45° field of view.
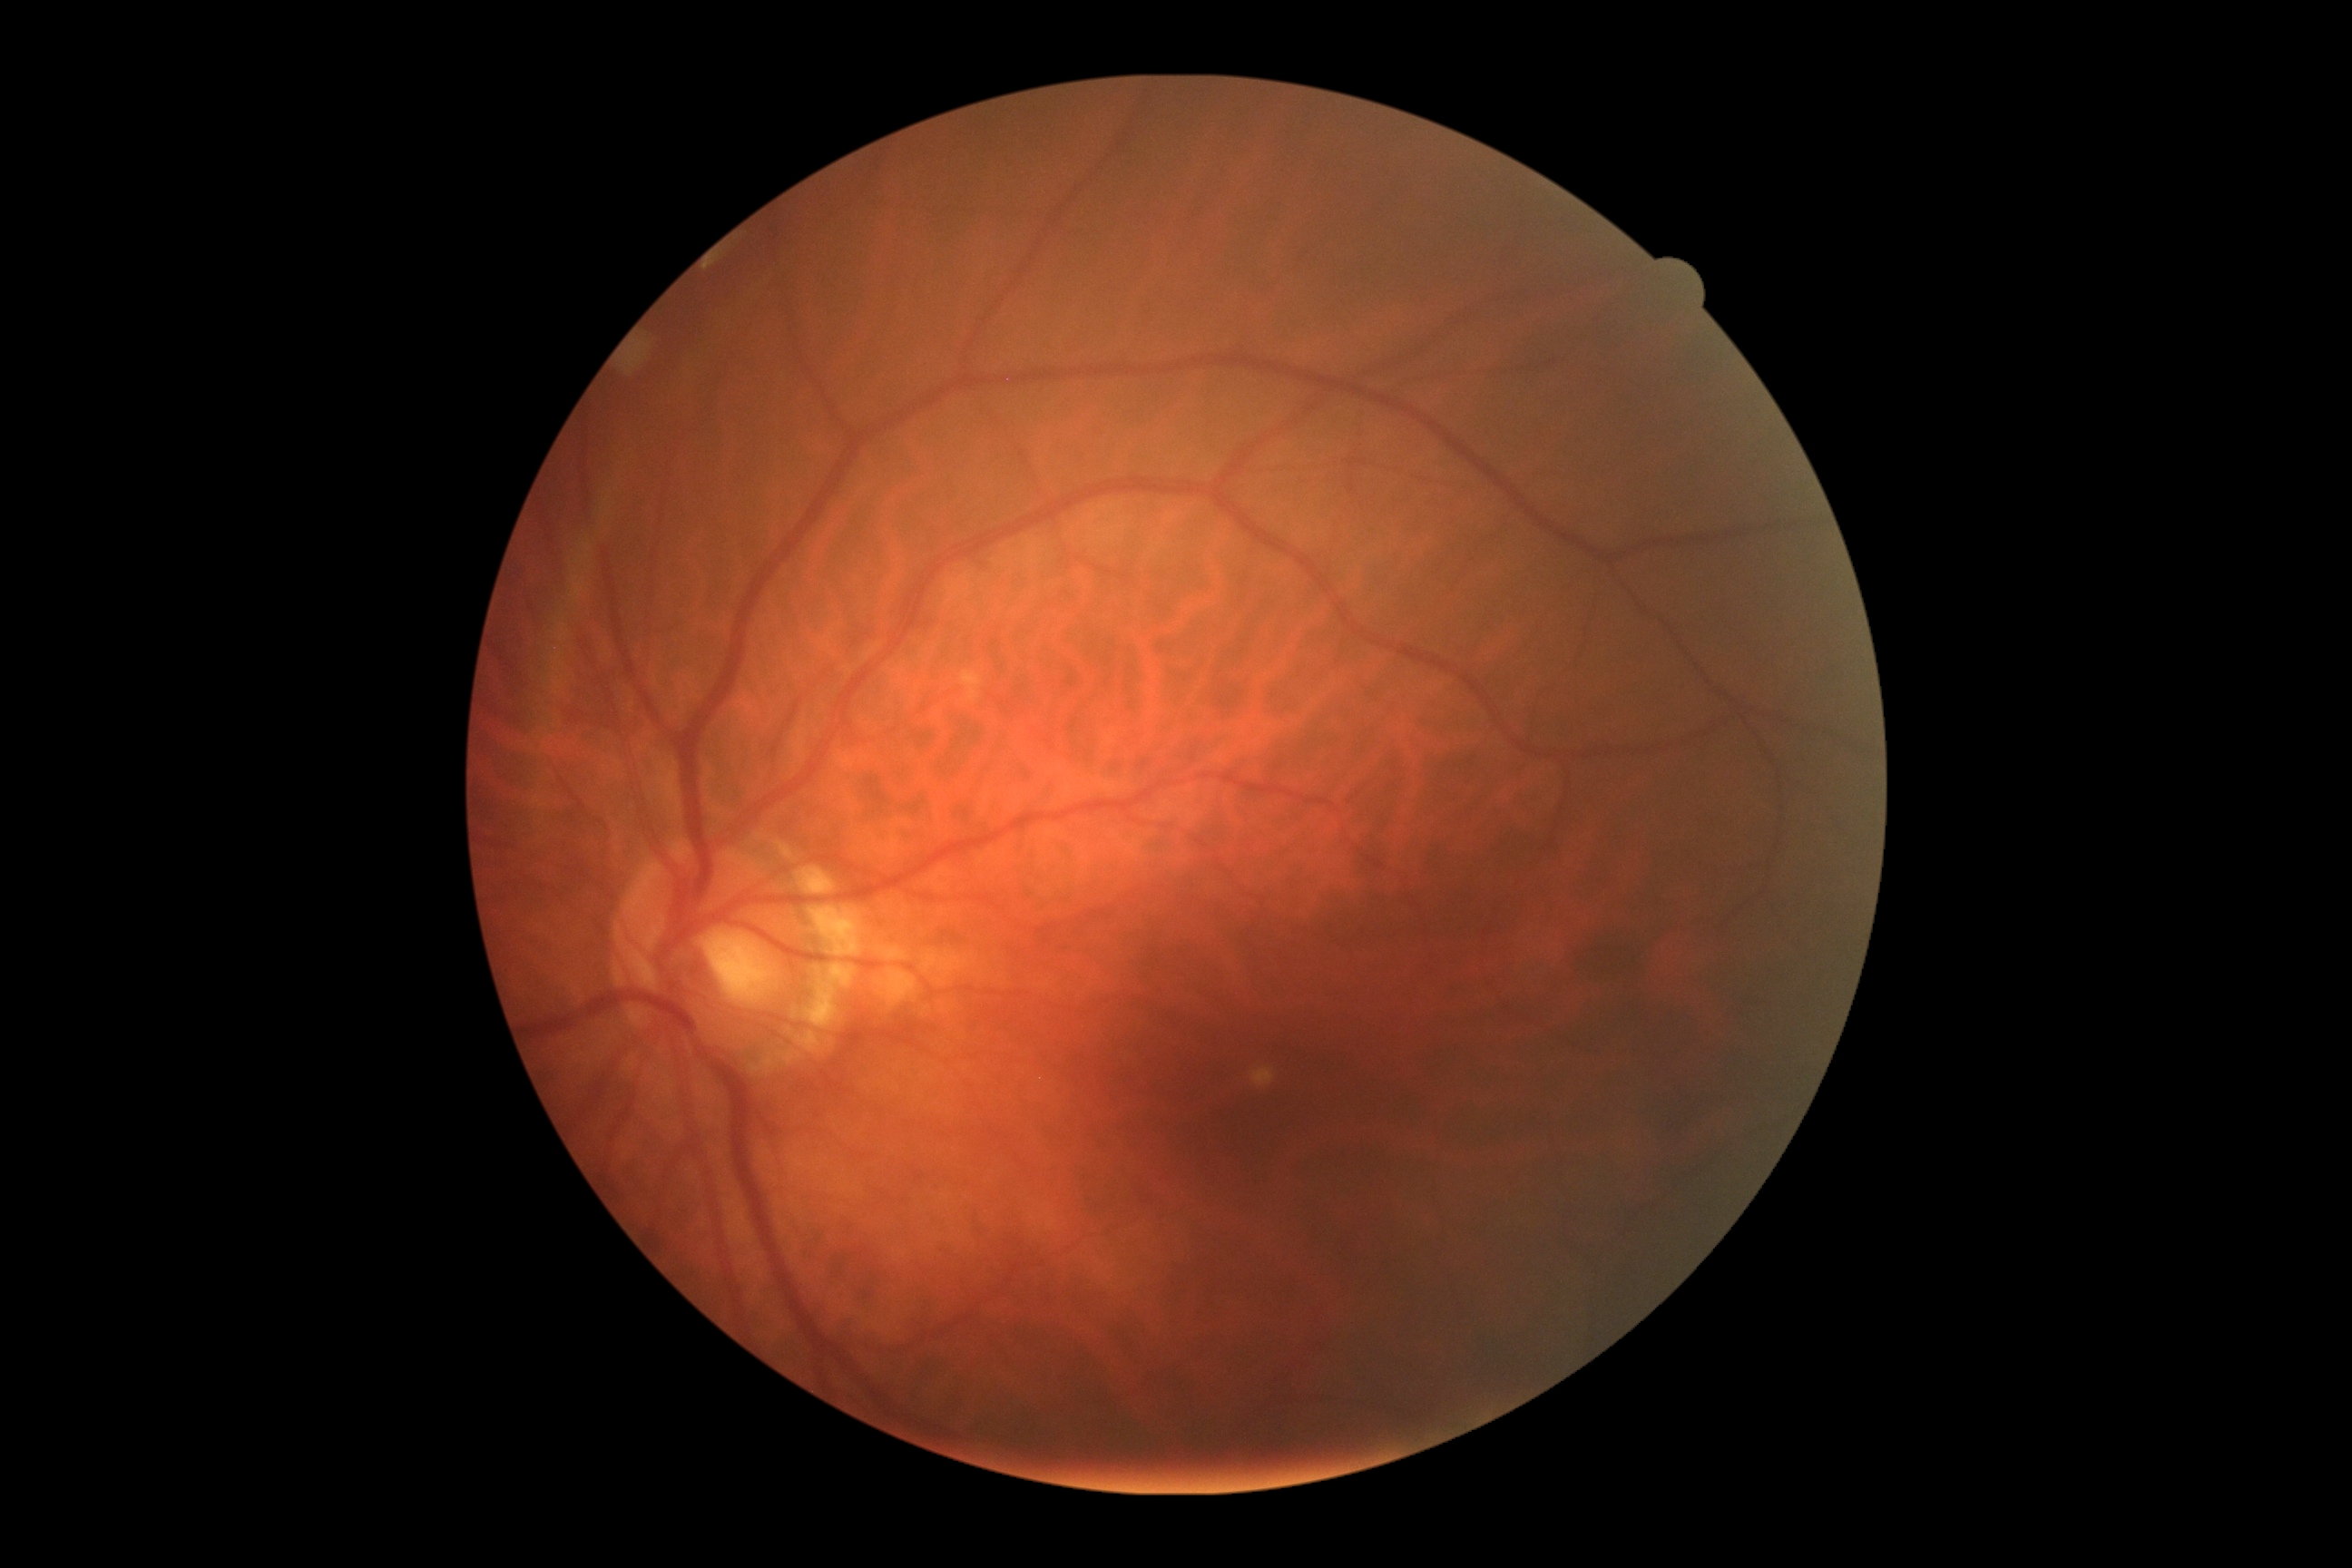

Diabetic retinopathy severity: no apparent retinopathy (grade 0) — no visible signs of diabetic retinopathy. No DR findings.